Color fundus image. 45 degree fundus photograph:
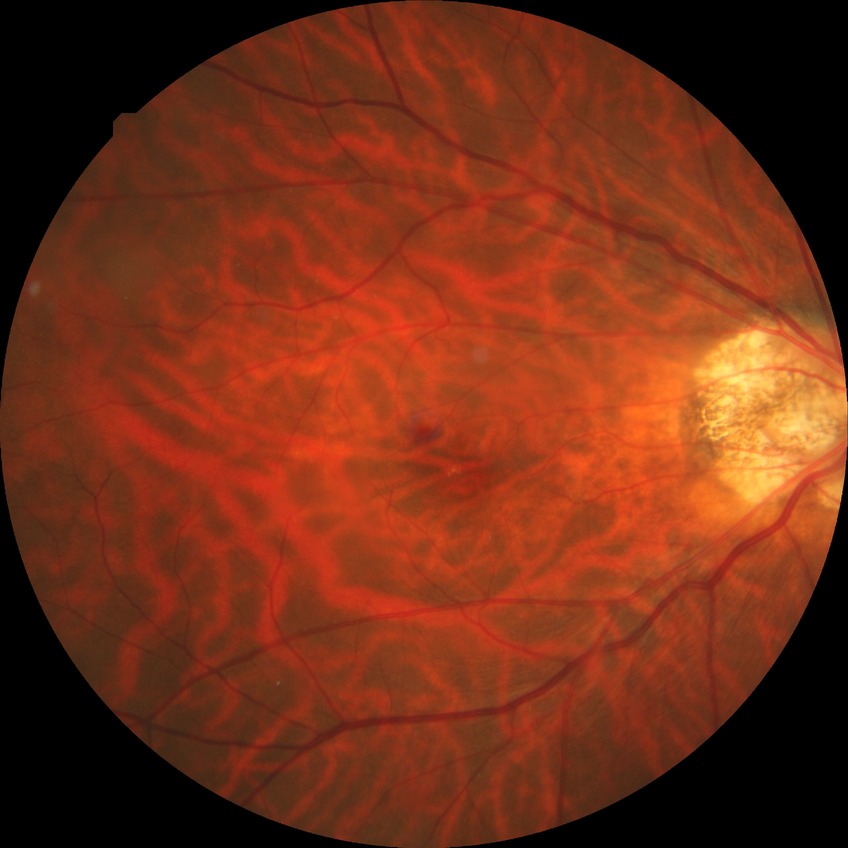

No diabetic retinal disease findings.
Davis grade: NDR.